Wide-field contact fundus photograph of an infant:
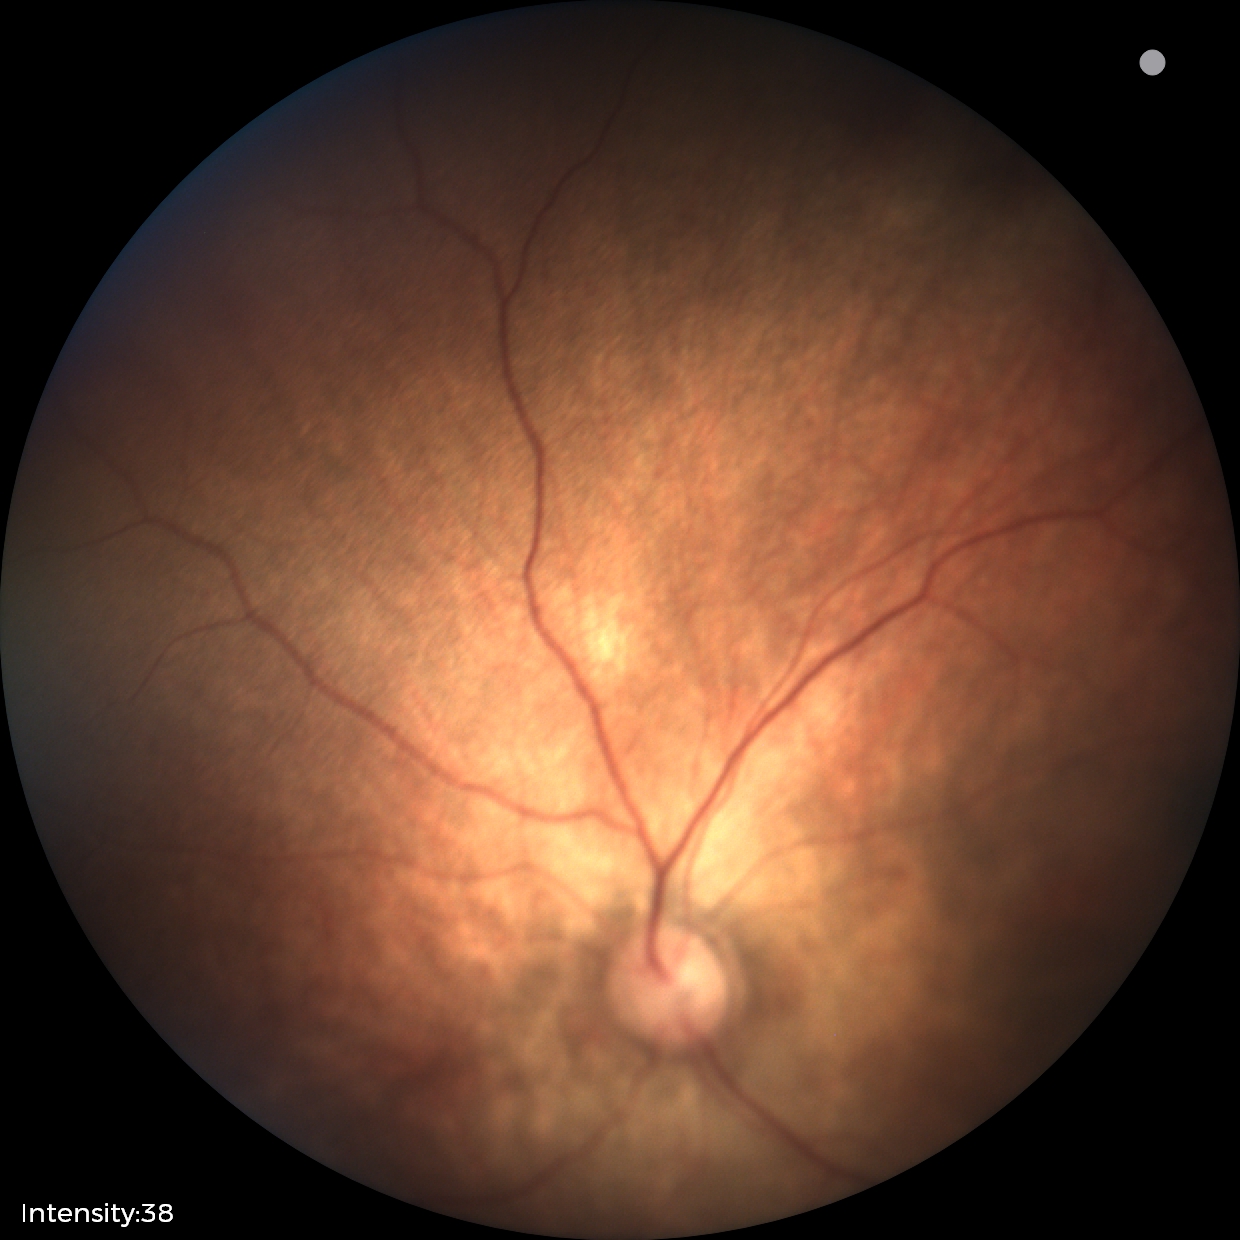 Screening: normal fundus examination.